Pediatric wide-field fundus photograph:
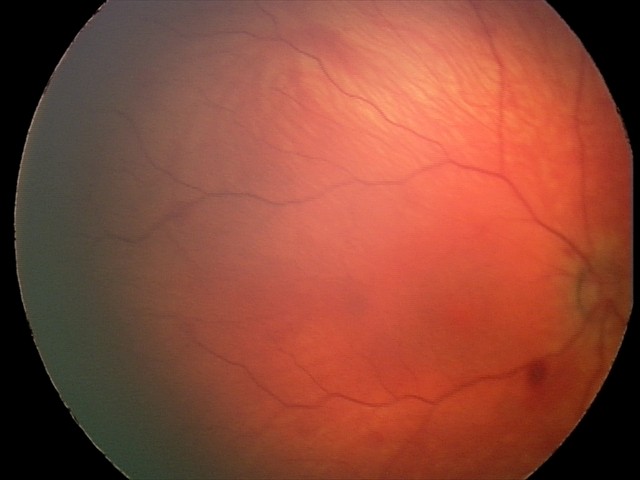
Examination diagnosed as retinal hemorrhages.